412x310. 45° field of view.
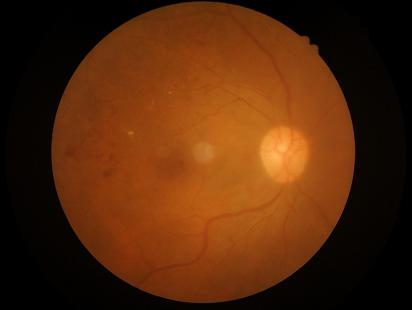 Good dynamic range.
No over- or under-exposure.
Image is sharp throughout the field.
Overall image quality is good.